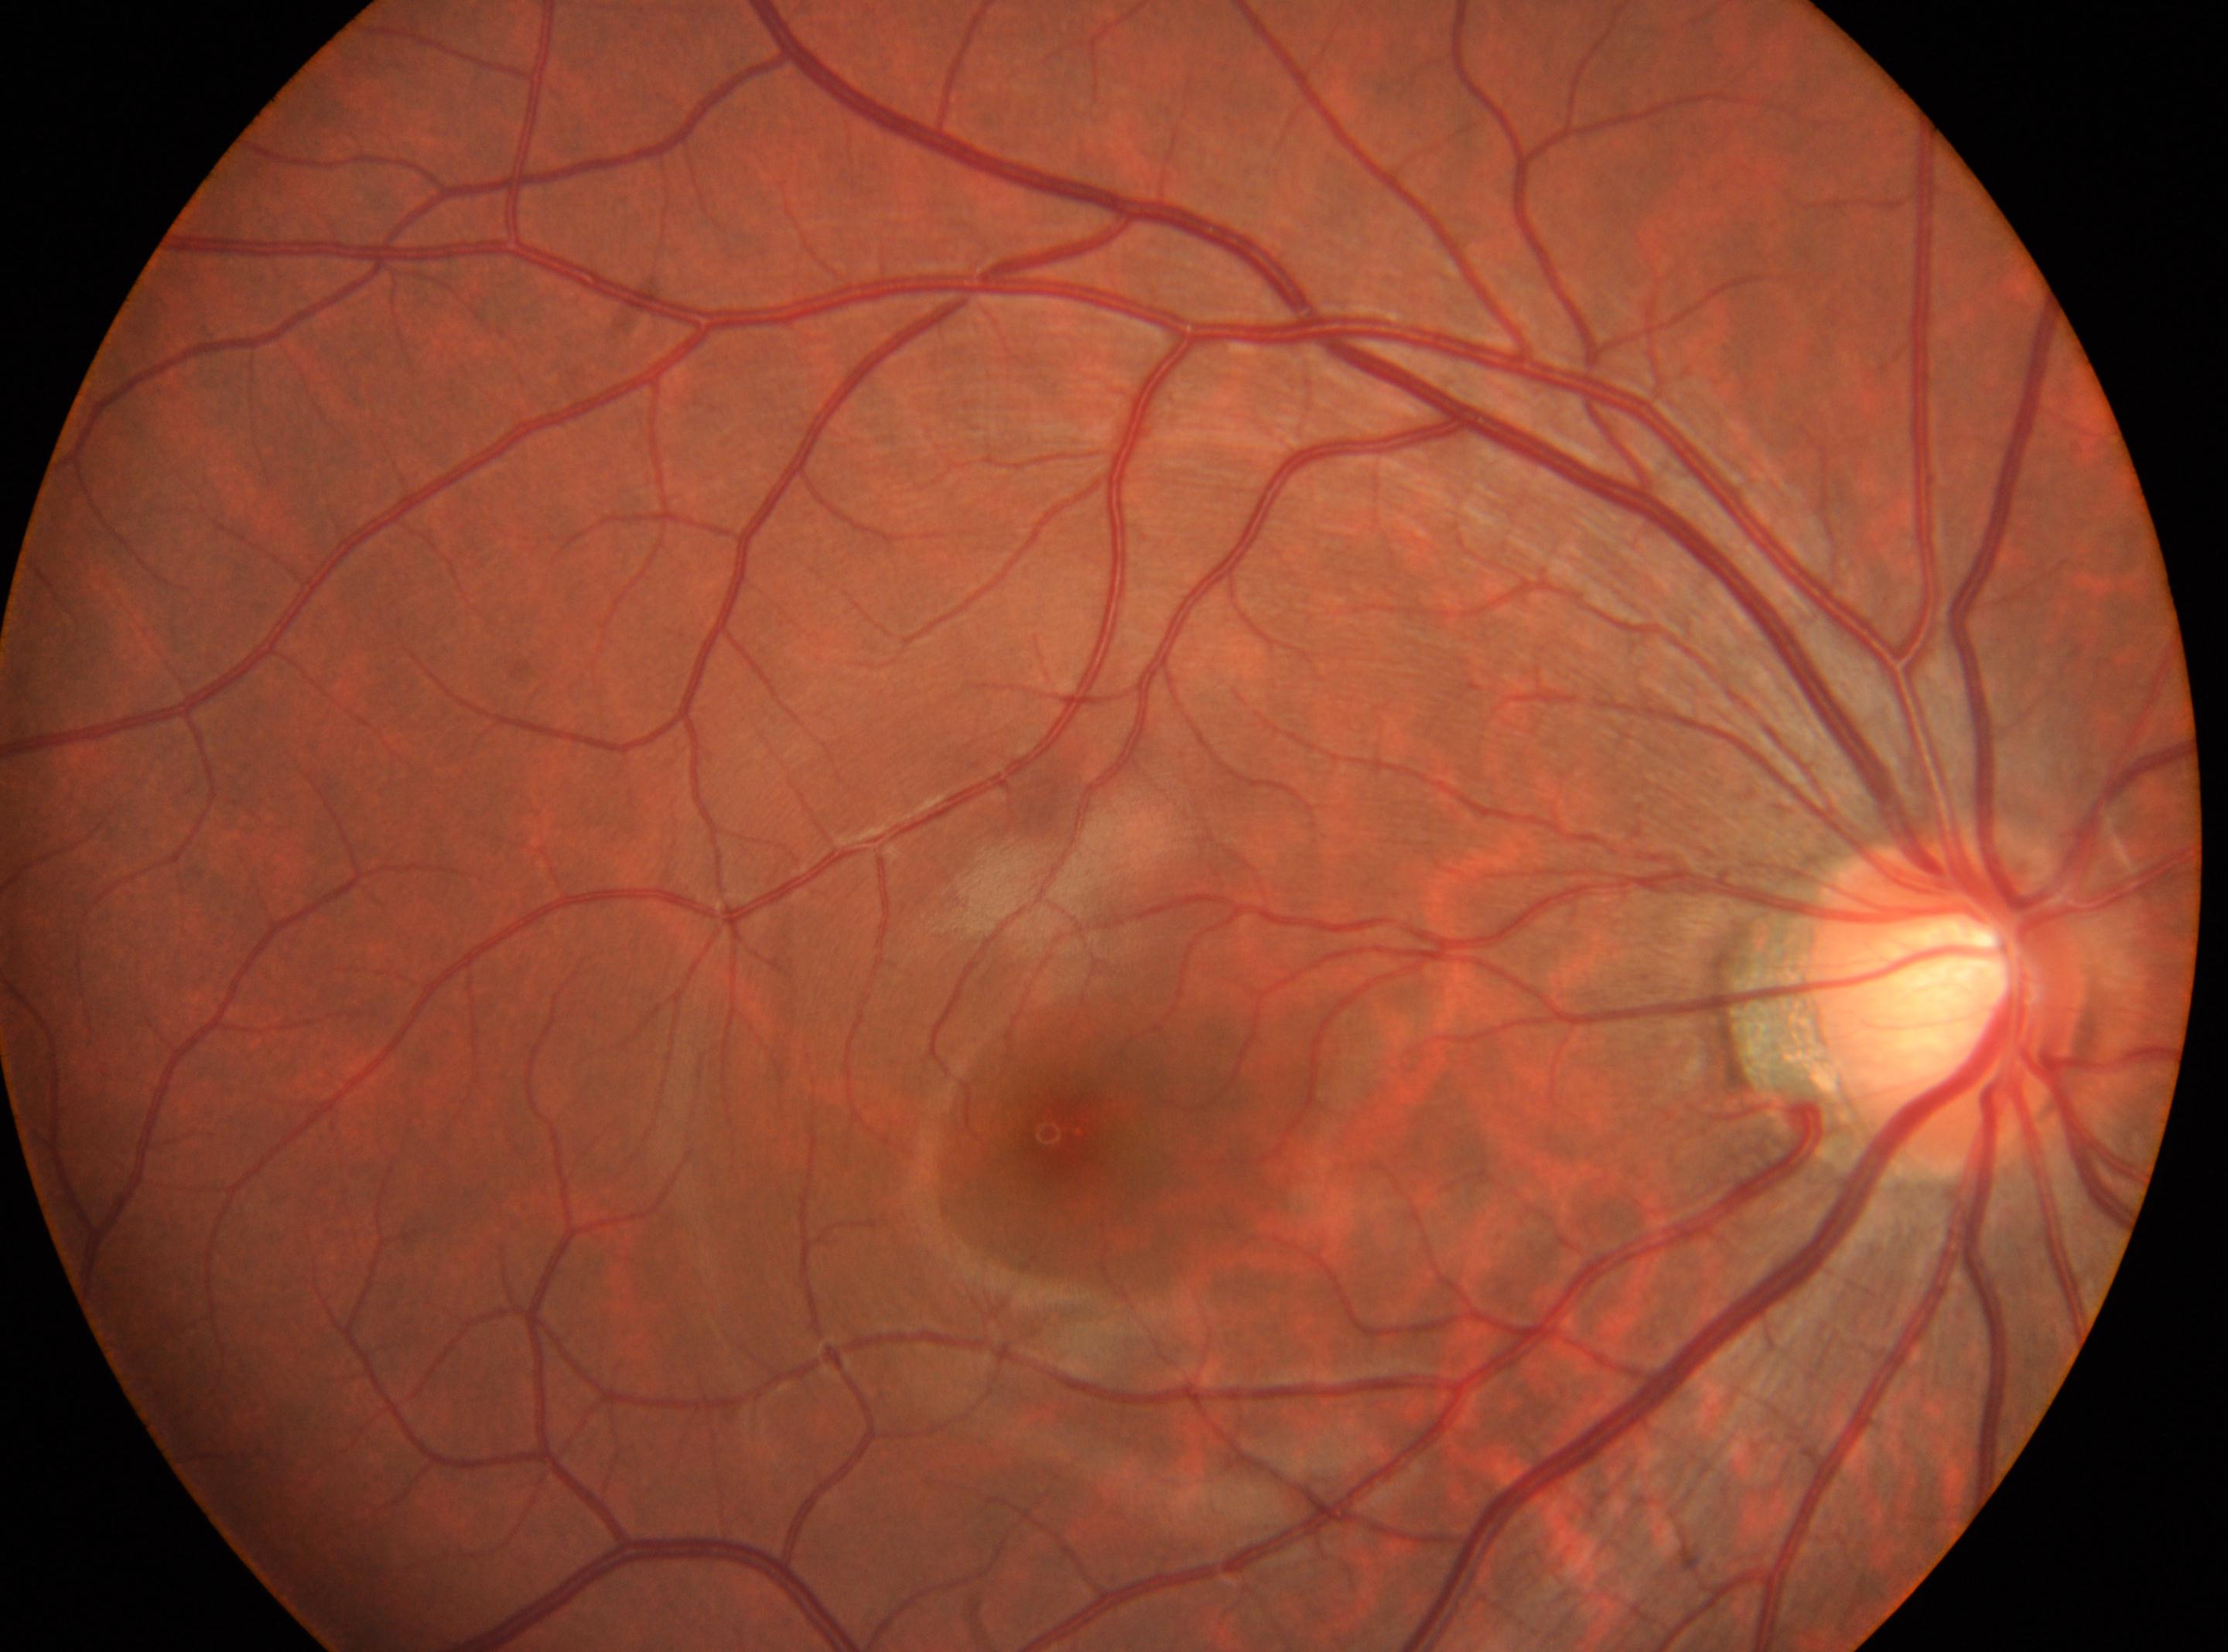 This is the right eye. Diabetic retinopathy severity: no apparent retinopathy (grade 0). Optic disk located at [1943, 1001]. No signs of diabetic retinopathy. The macula center is at [1058, 1134].